Nonmydriatic.
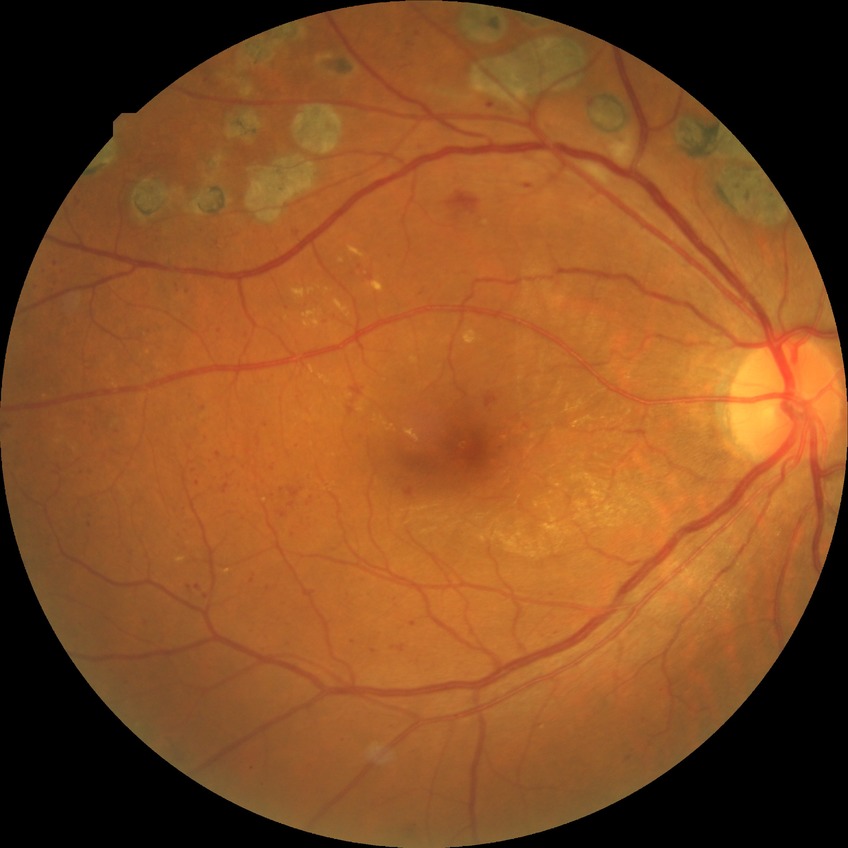

Annotations:
* retinopathy grade — proliferative diabetic retinopathy